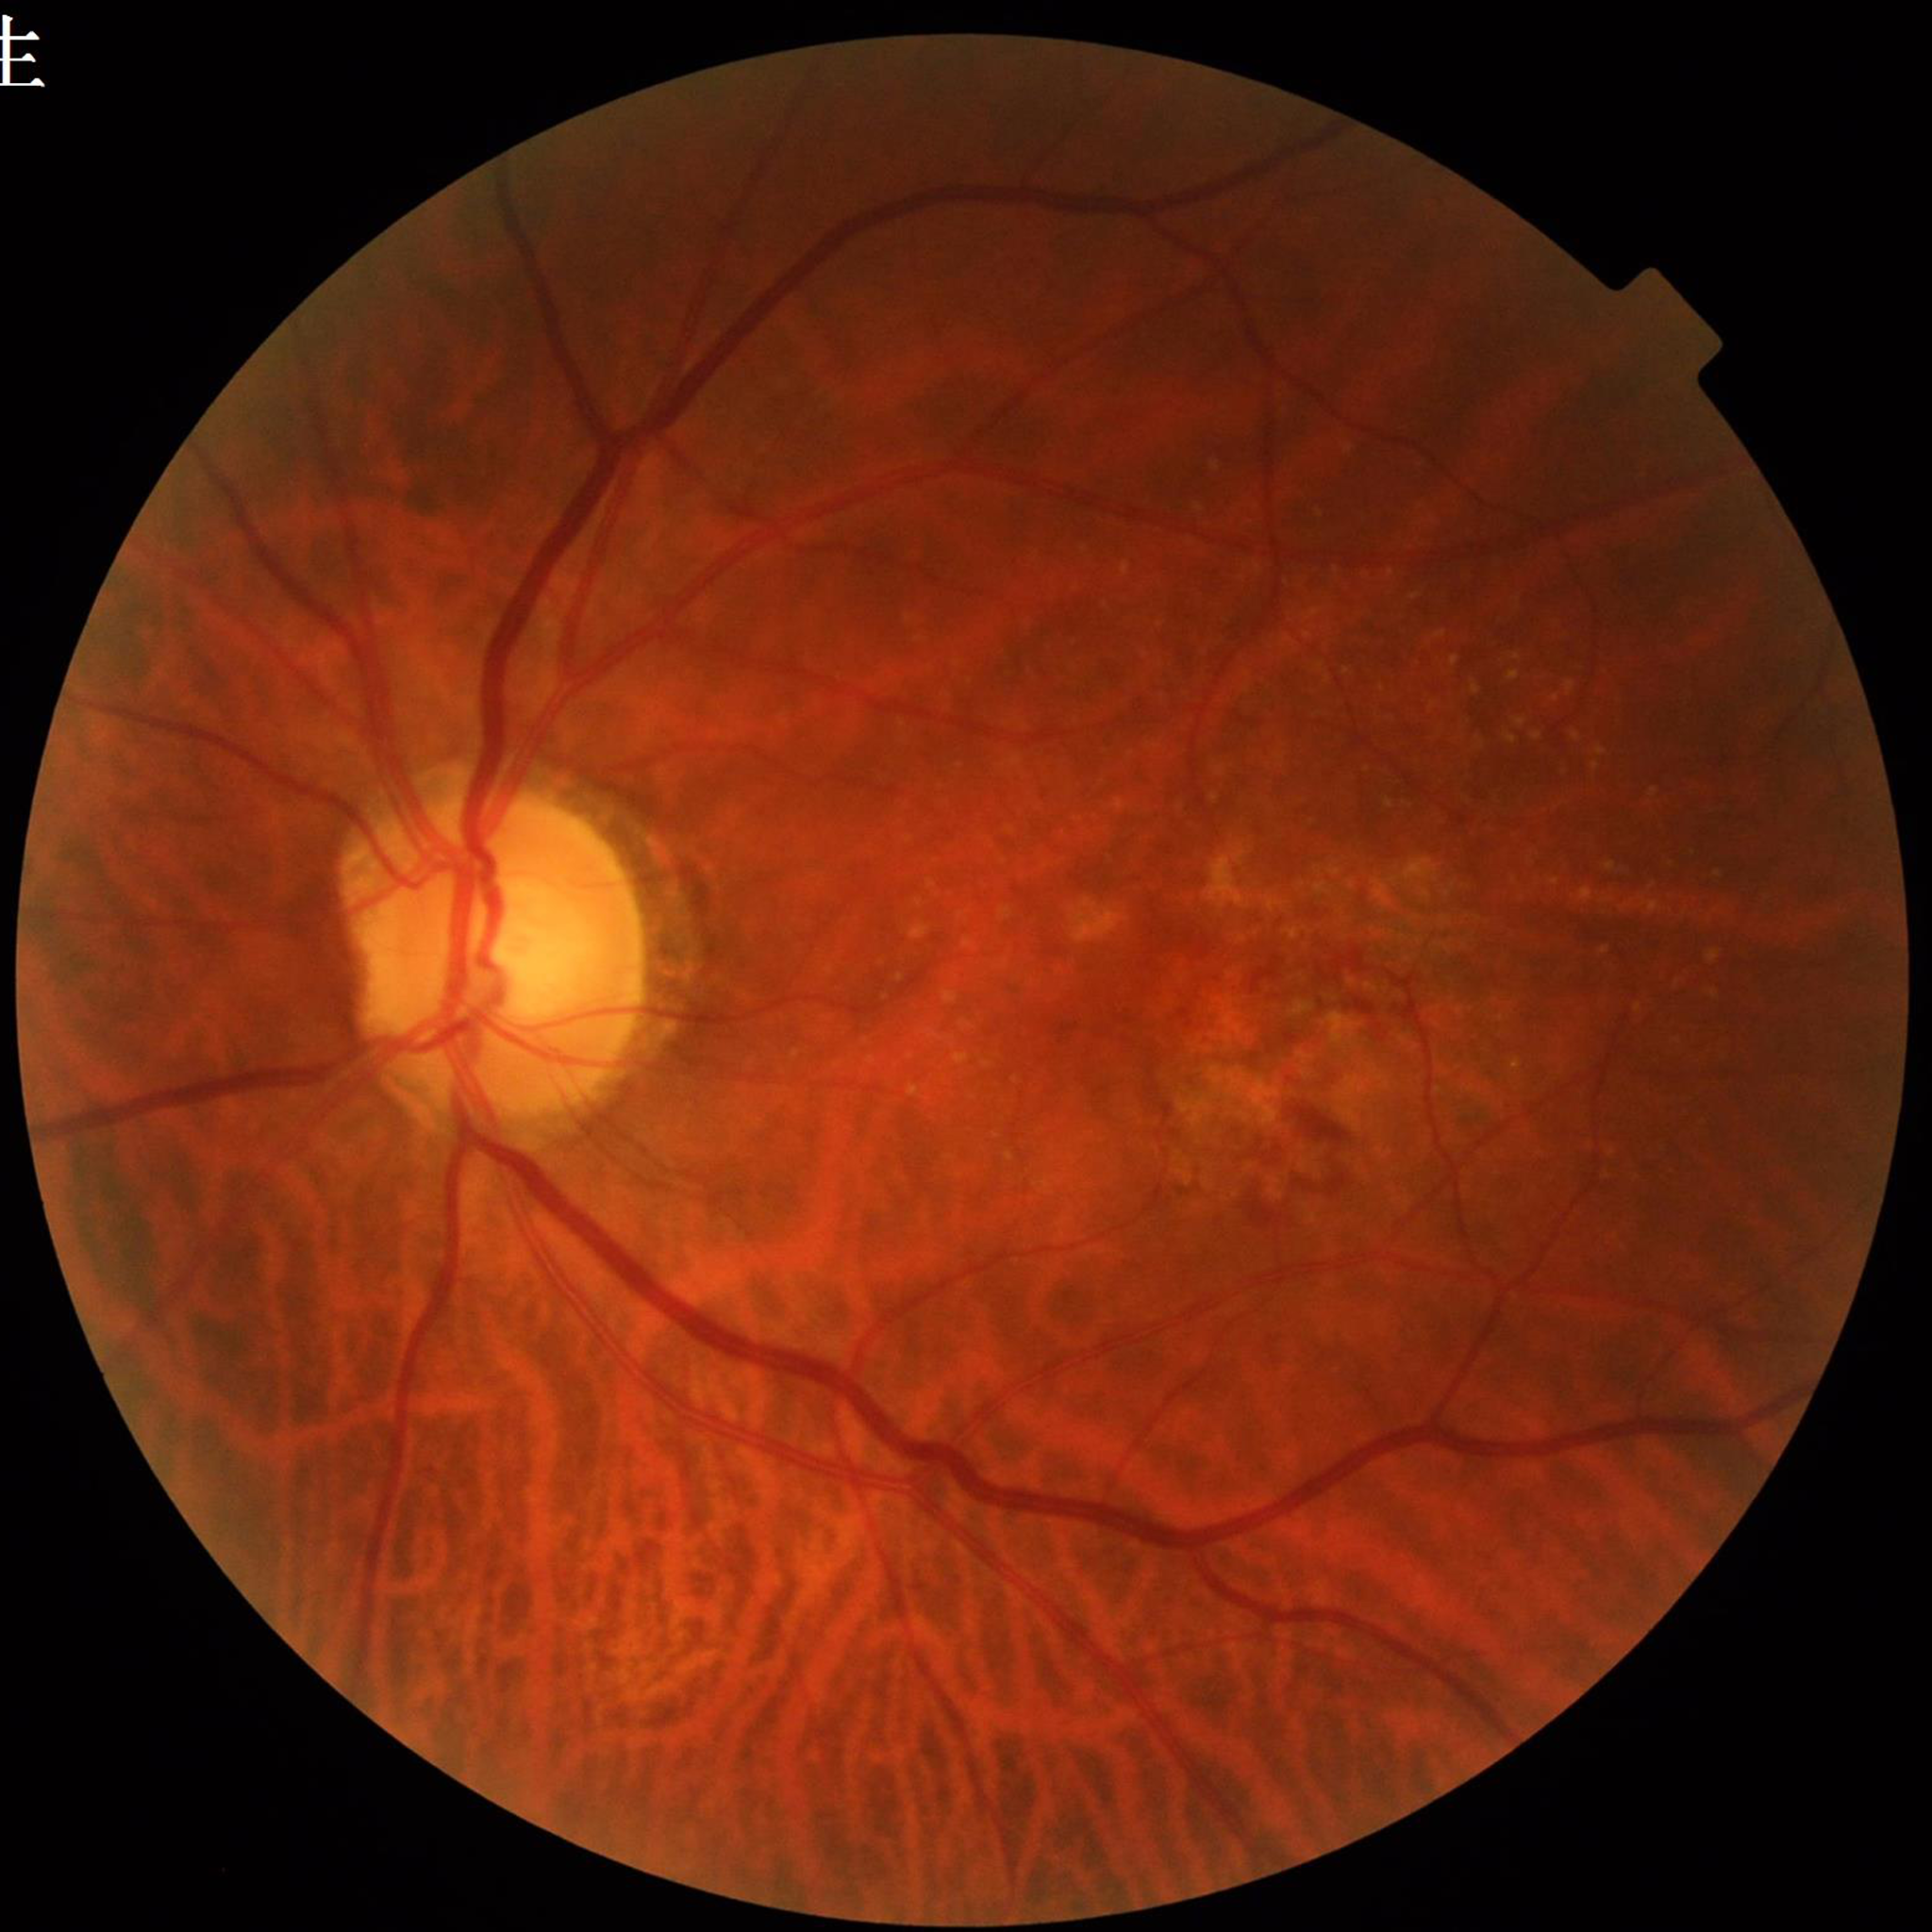
Clinical diagnosis = age-related macular degeneration